Retinal fundus photograph — 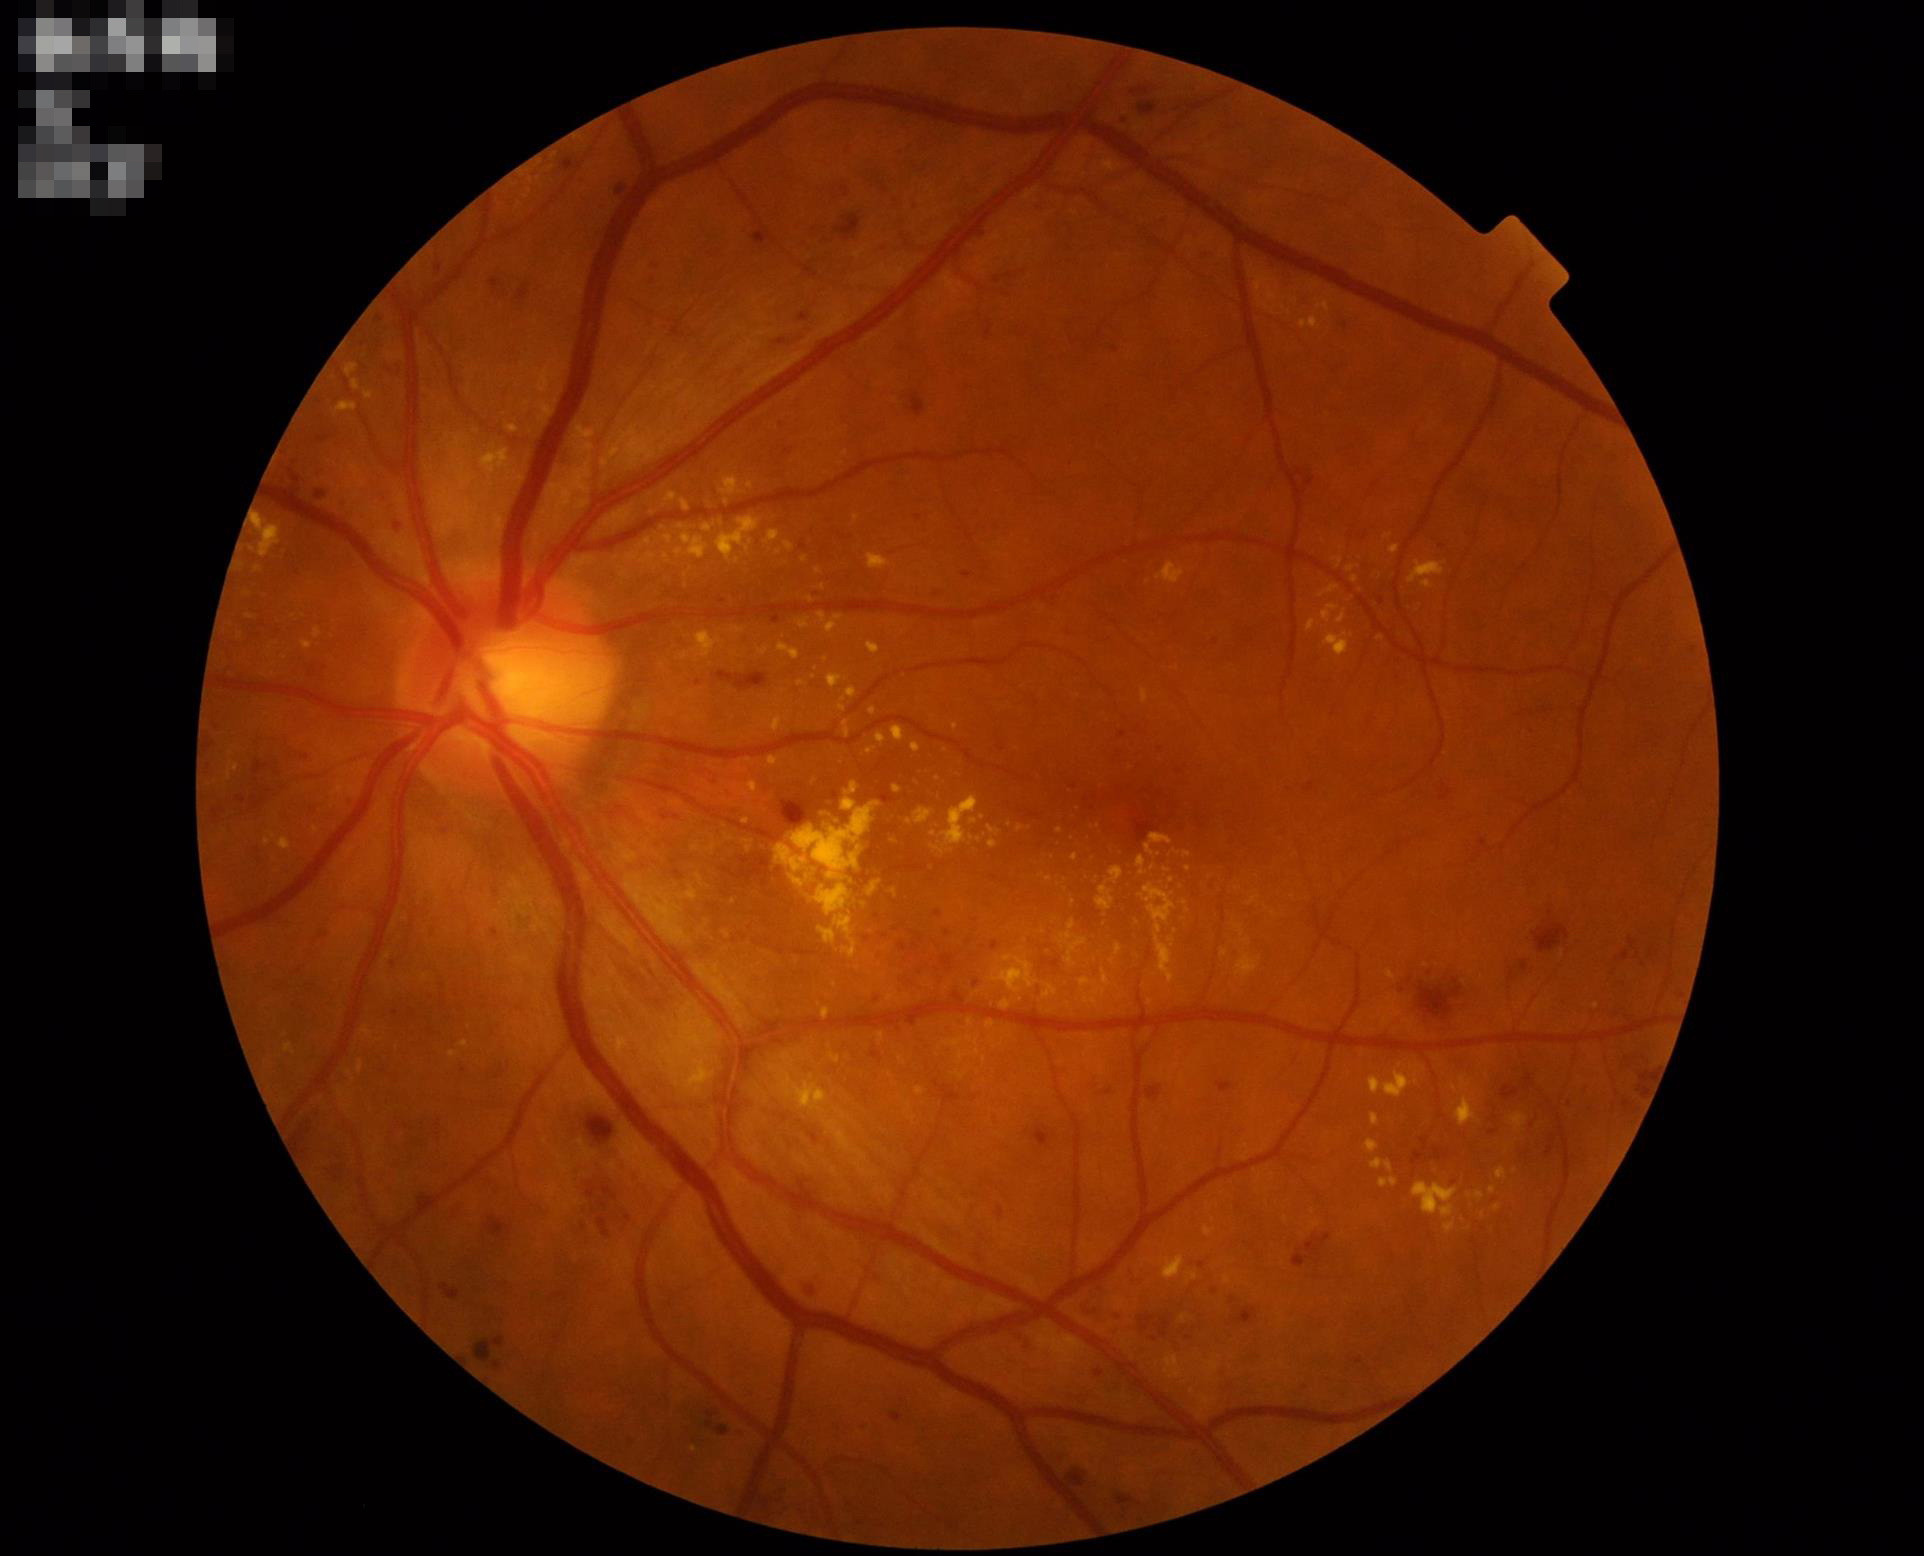 Quality grading: contrast: vessels and details readily distinguishable | overall: good and suitable for diagnostic use | illumination: no over- or under-exposure.